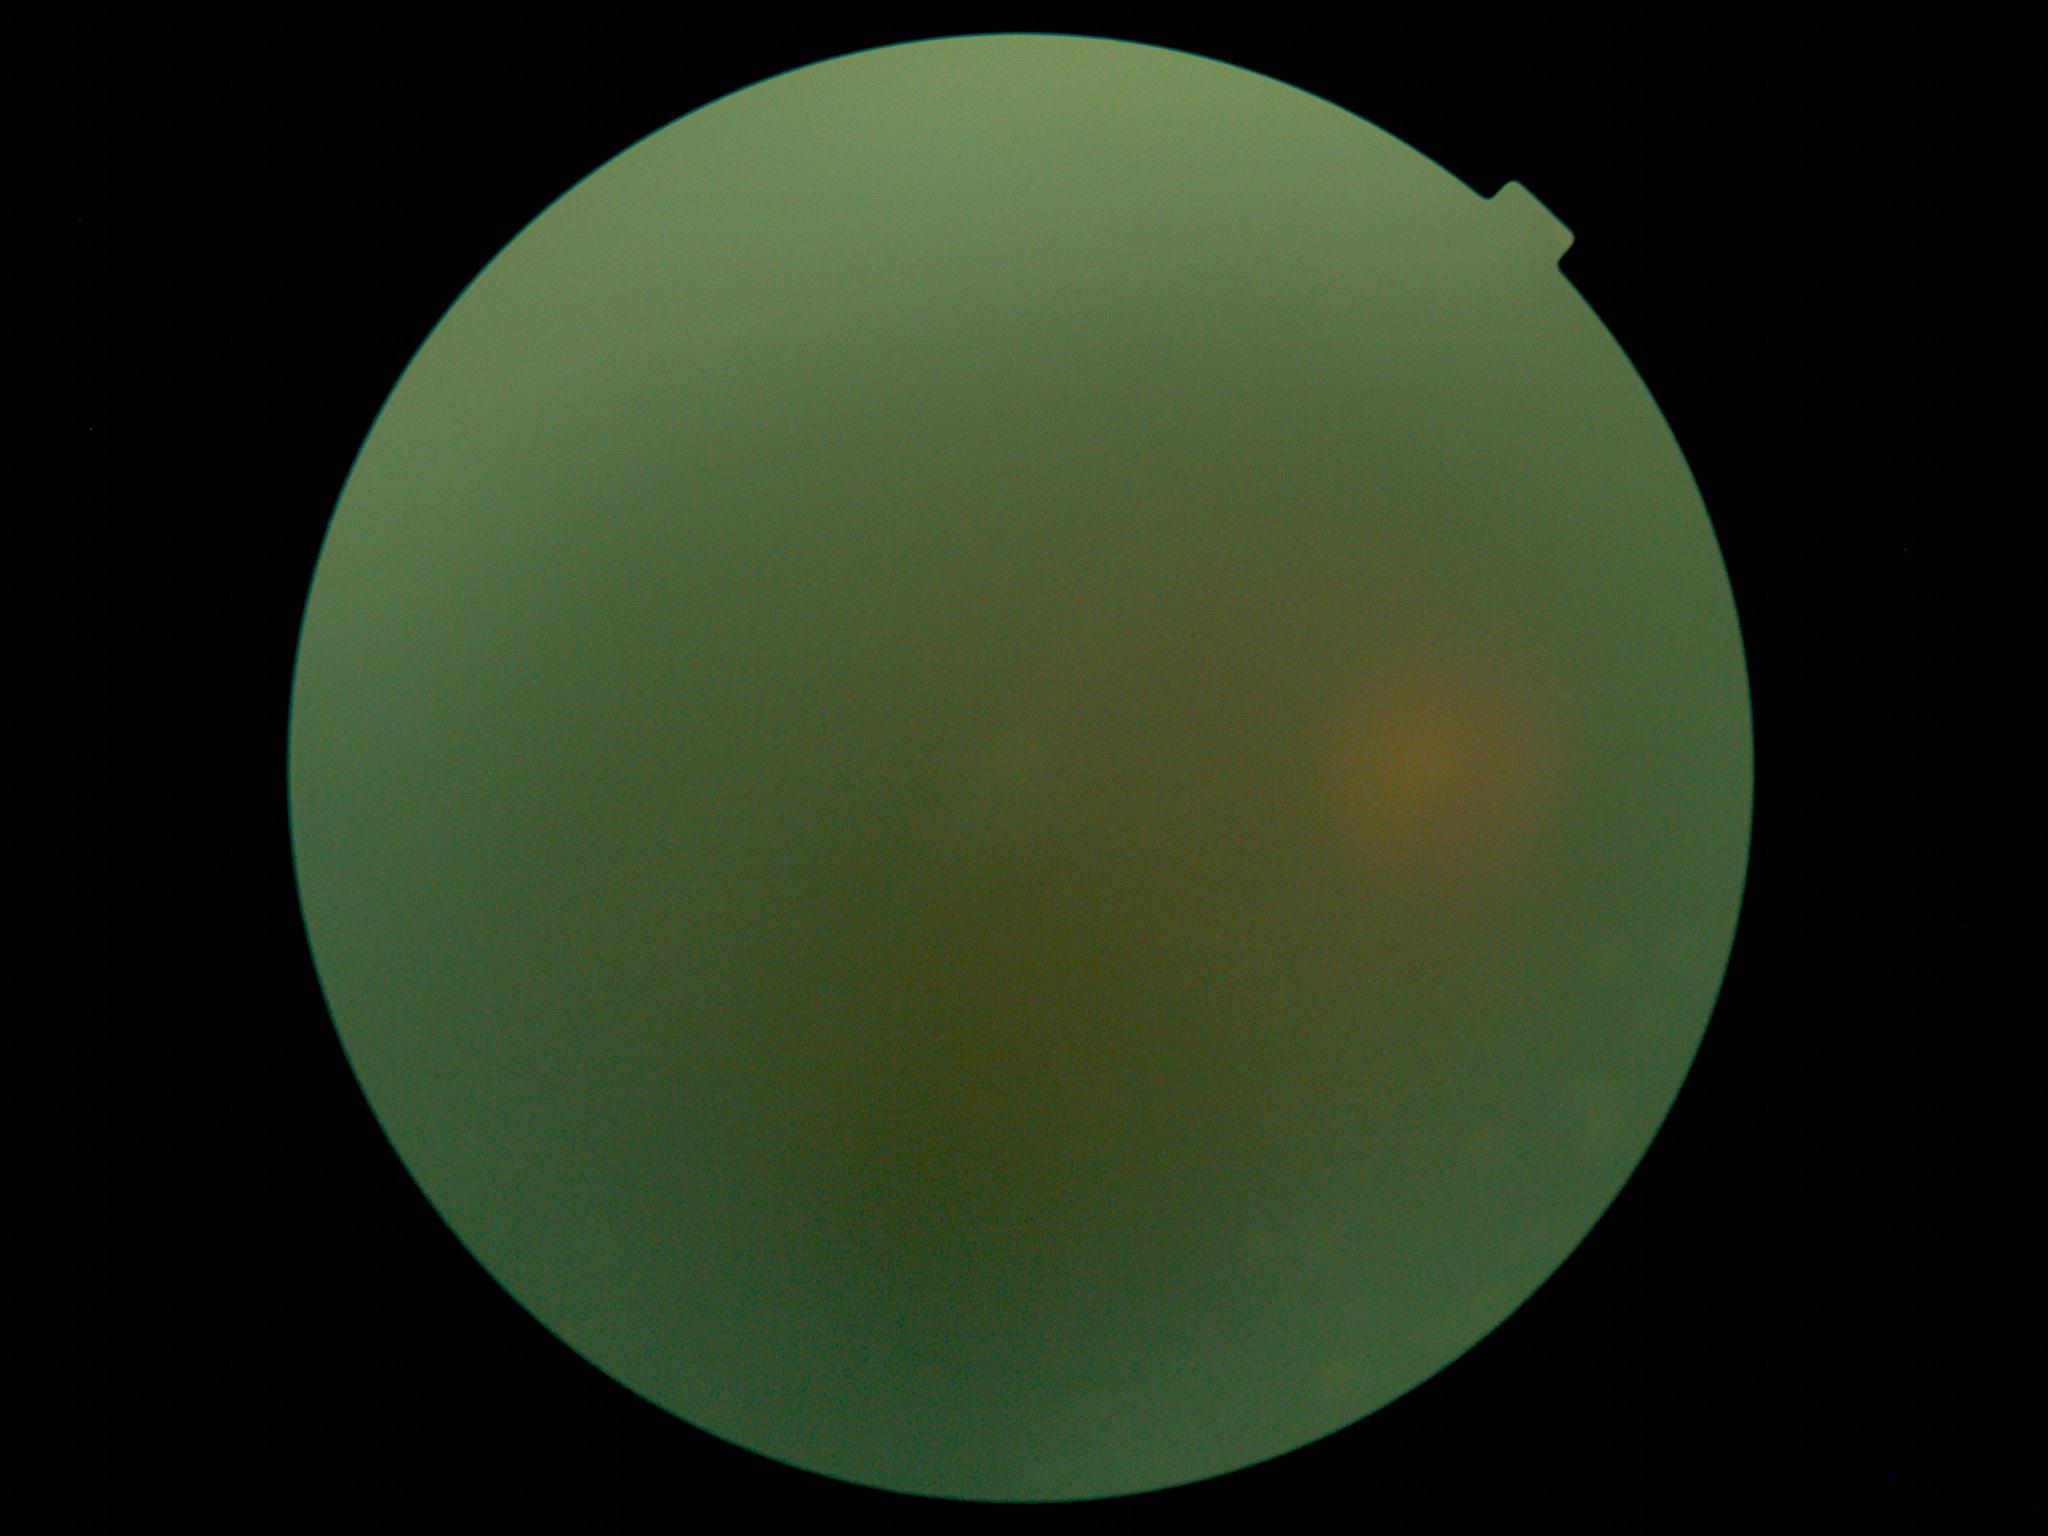
image quality: below grading threshold; DR severity: ungradable.